NIDEK AFC-230 fundus camera; 45 degree fundus photograph; image size 848x848; fundus photo.
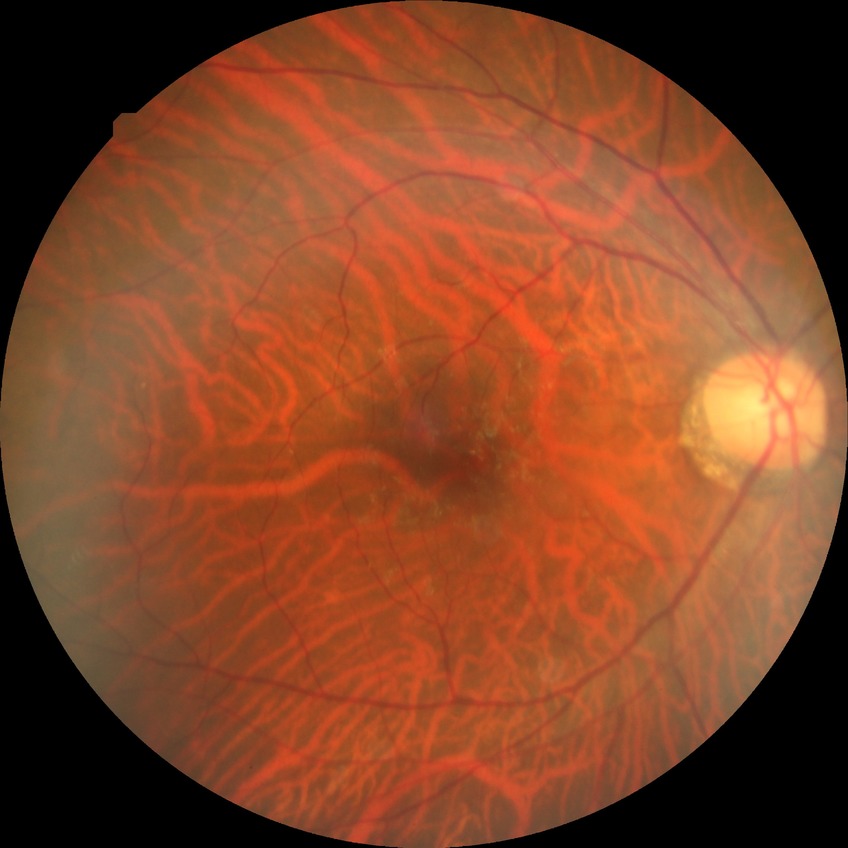
Retinopathy stage is no diabetic retinopathy.